Fundus photo taken with a portable handheld camera.
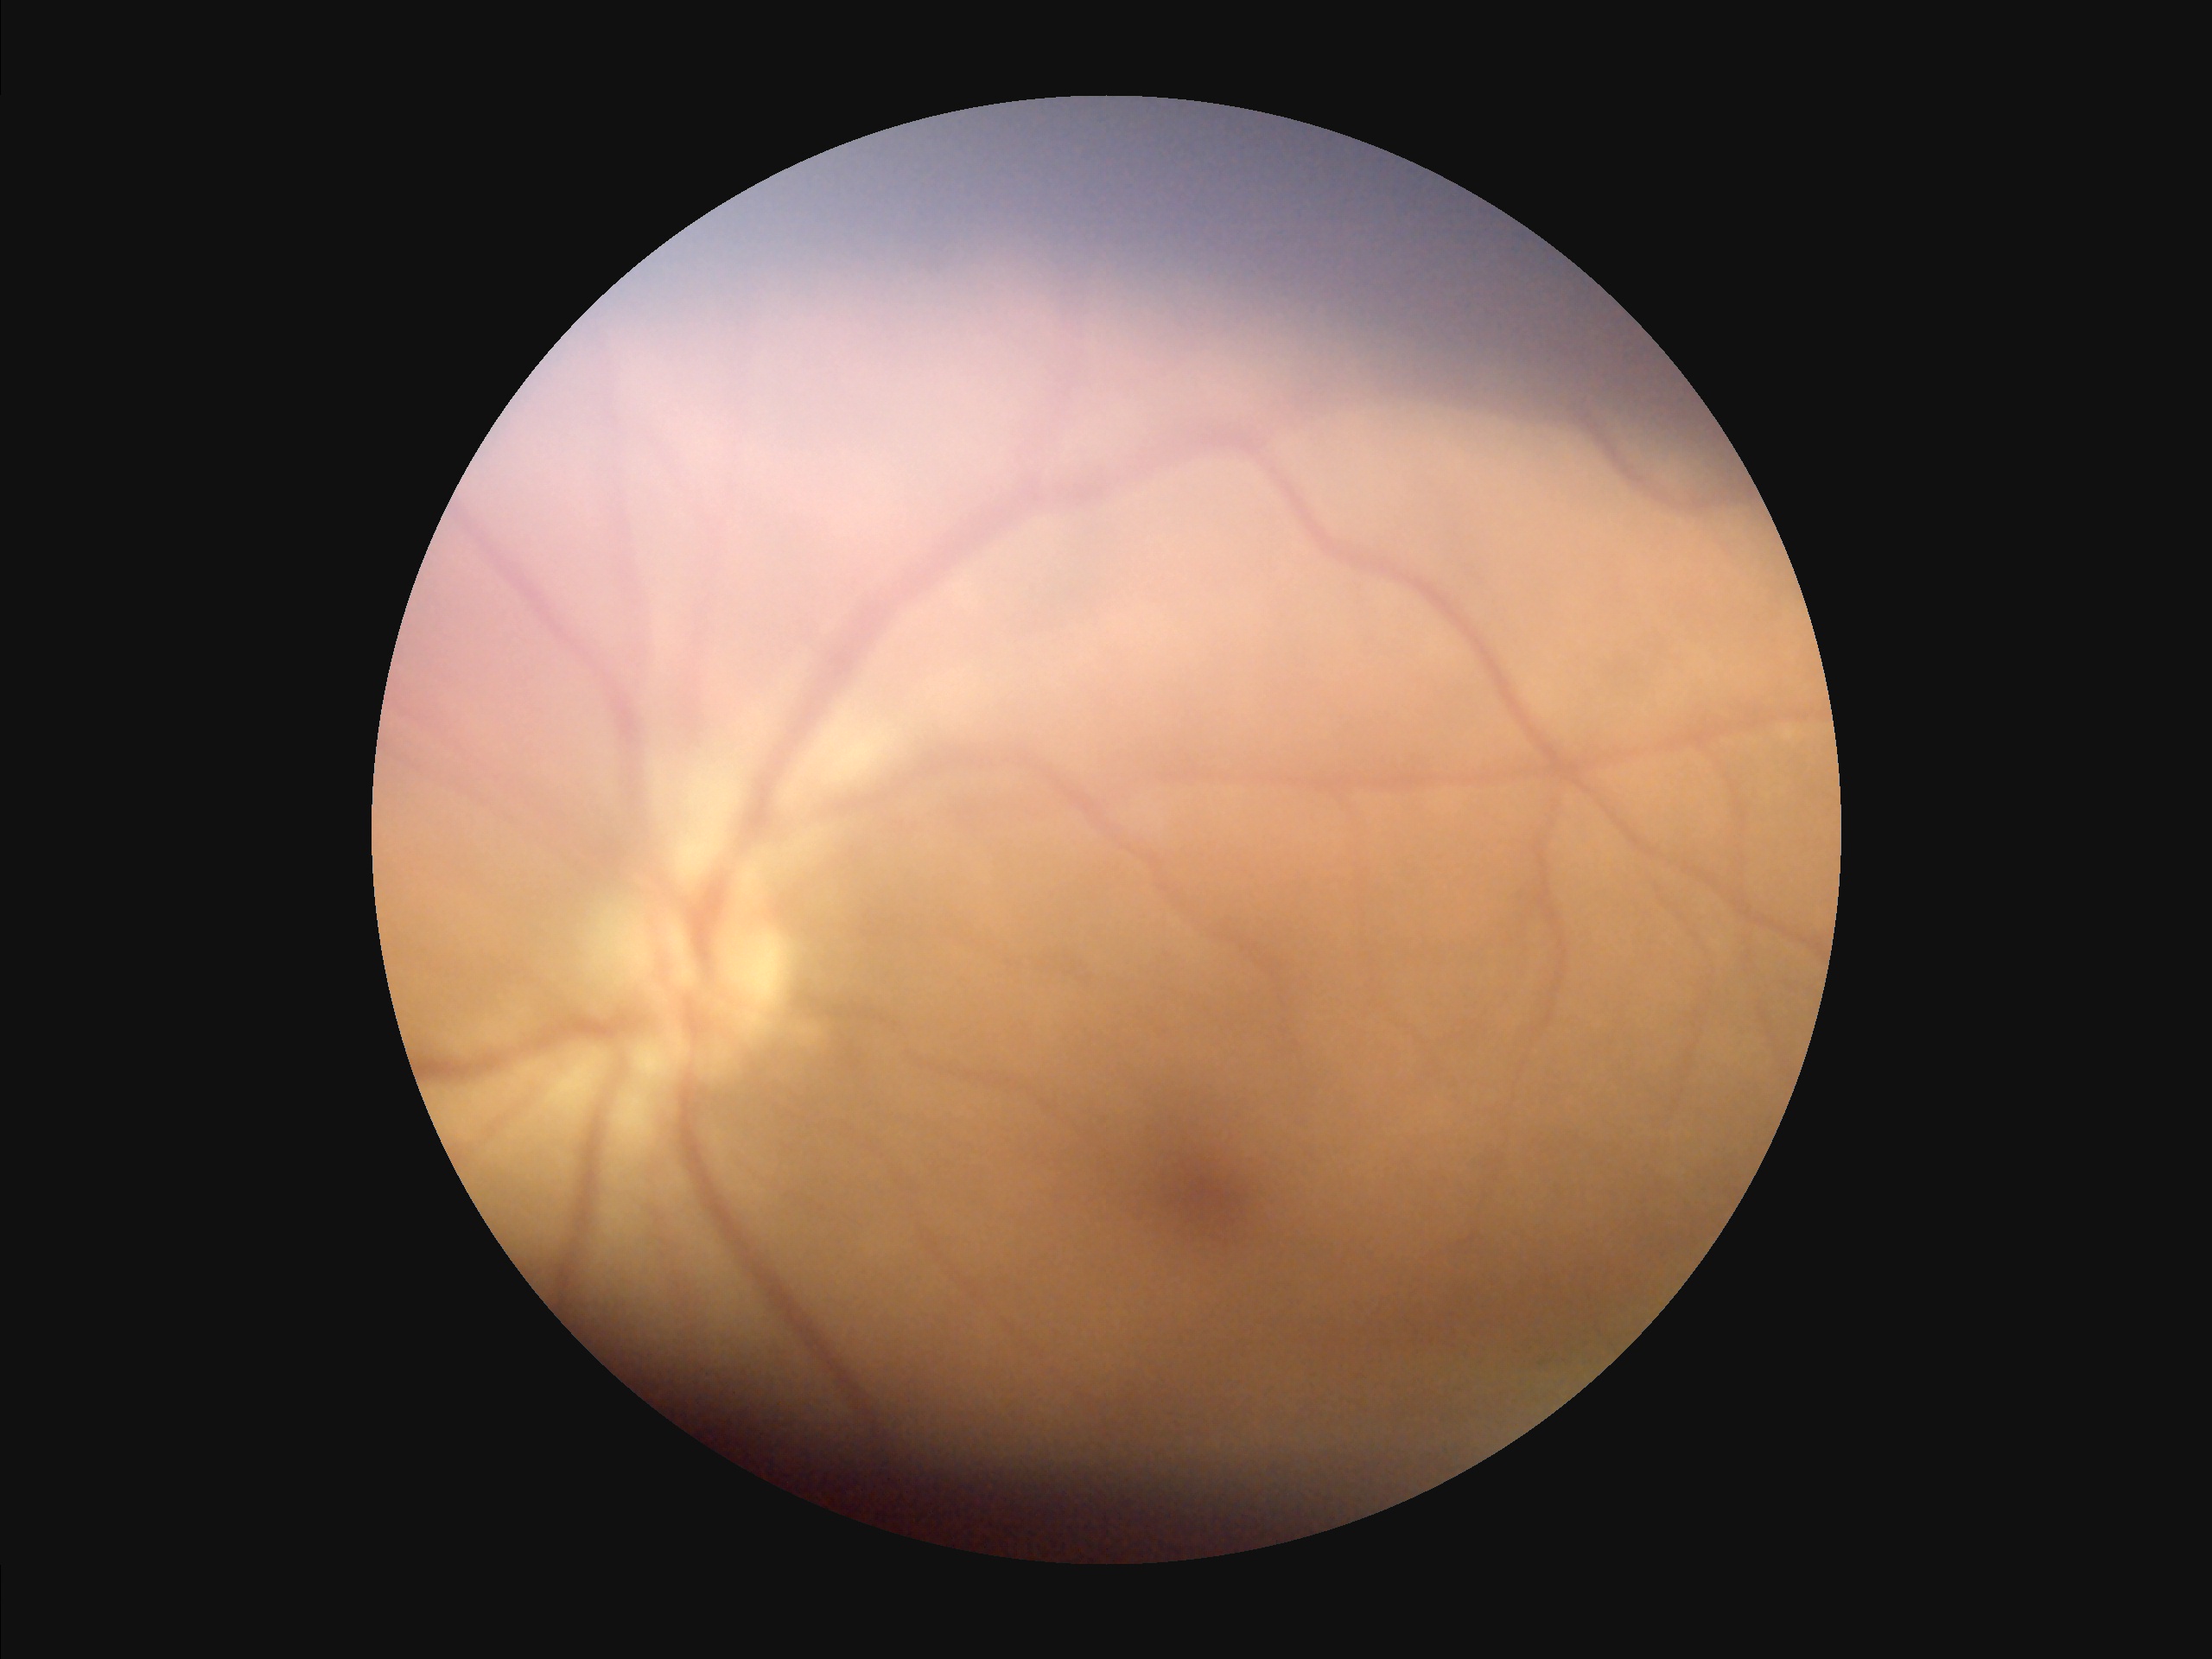 Good dynamic range.
Noticeable blur in the optic disc, vessels, or background.
Overall image quality is poor.
Illumination is uneven.